Acquired with a NIDEK AFC-230.
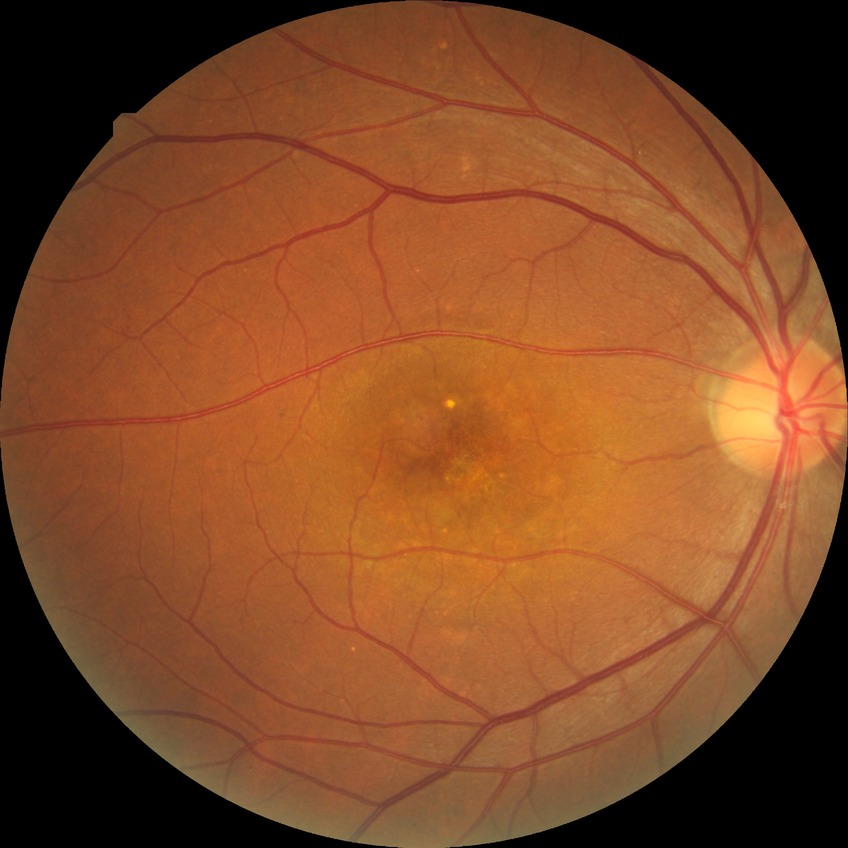

  davis_grade: NDR